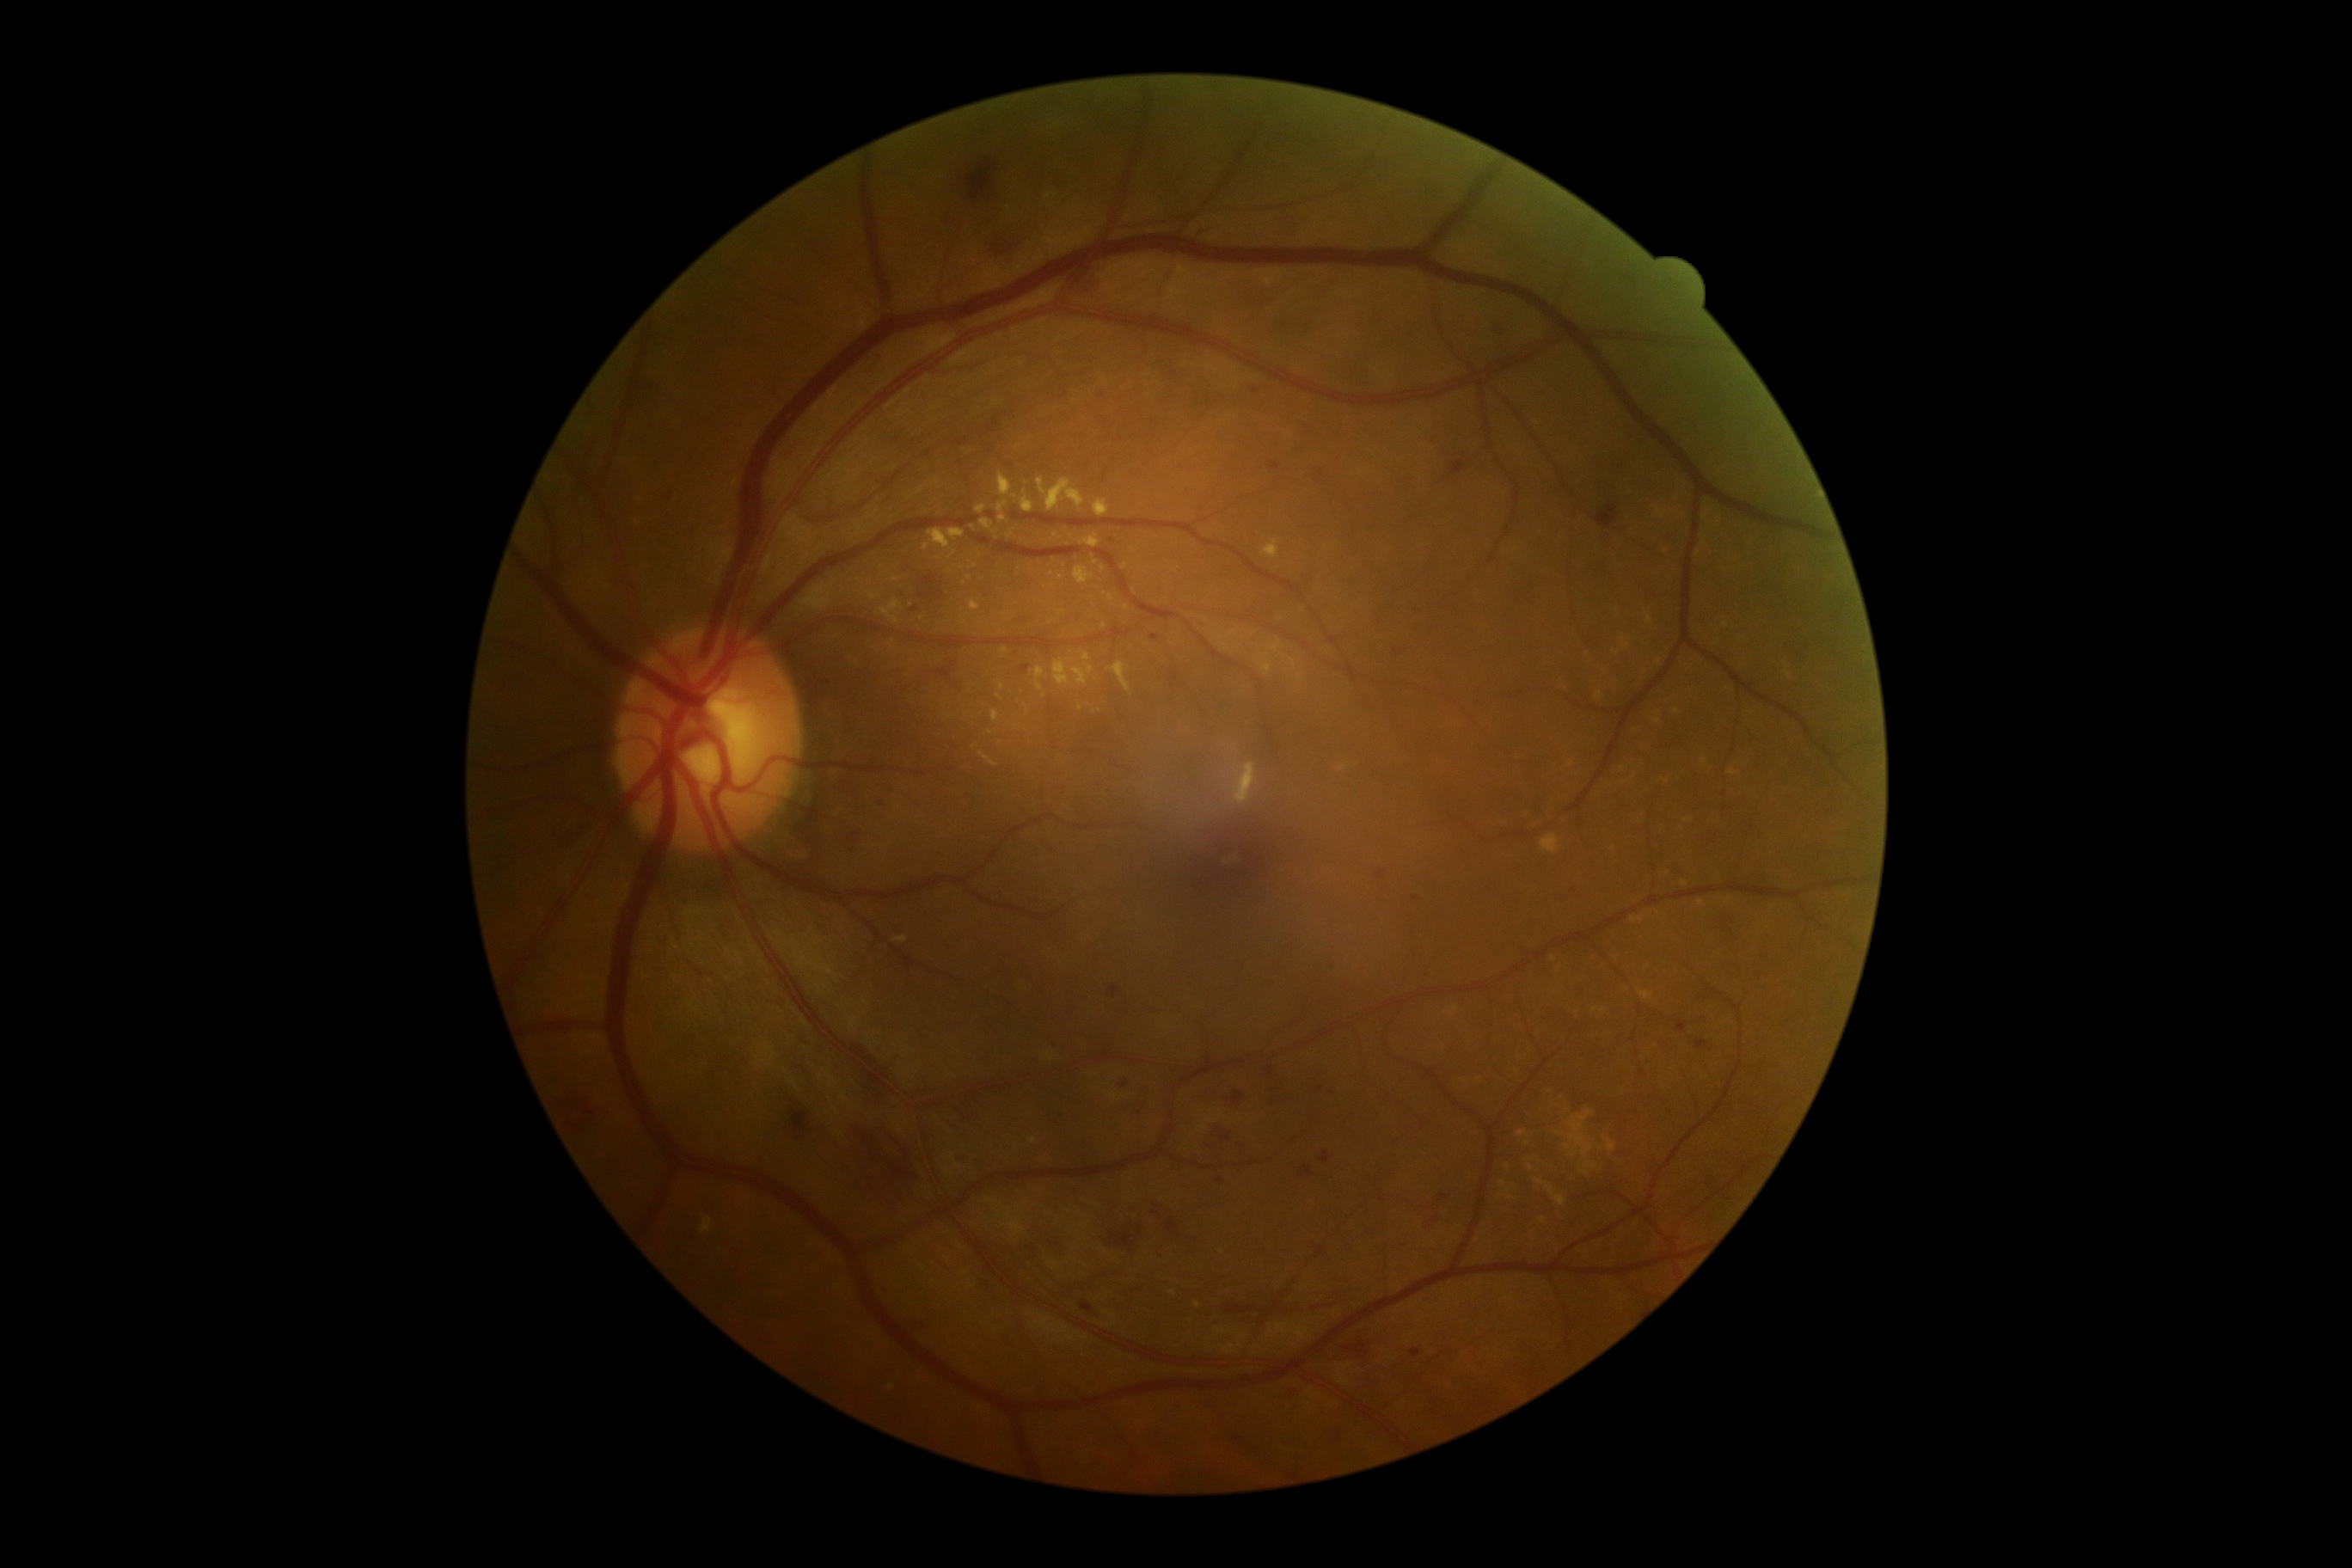 Annotations:
* diabetic retinopathy — moderate NPDR (grade 2)